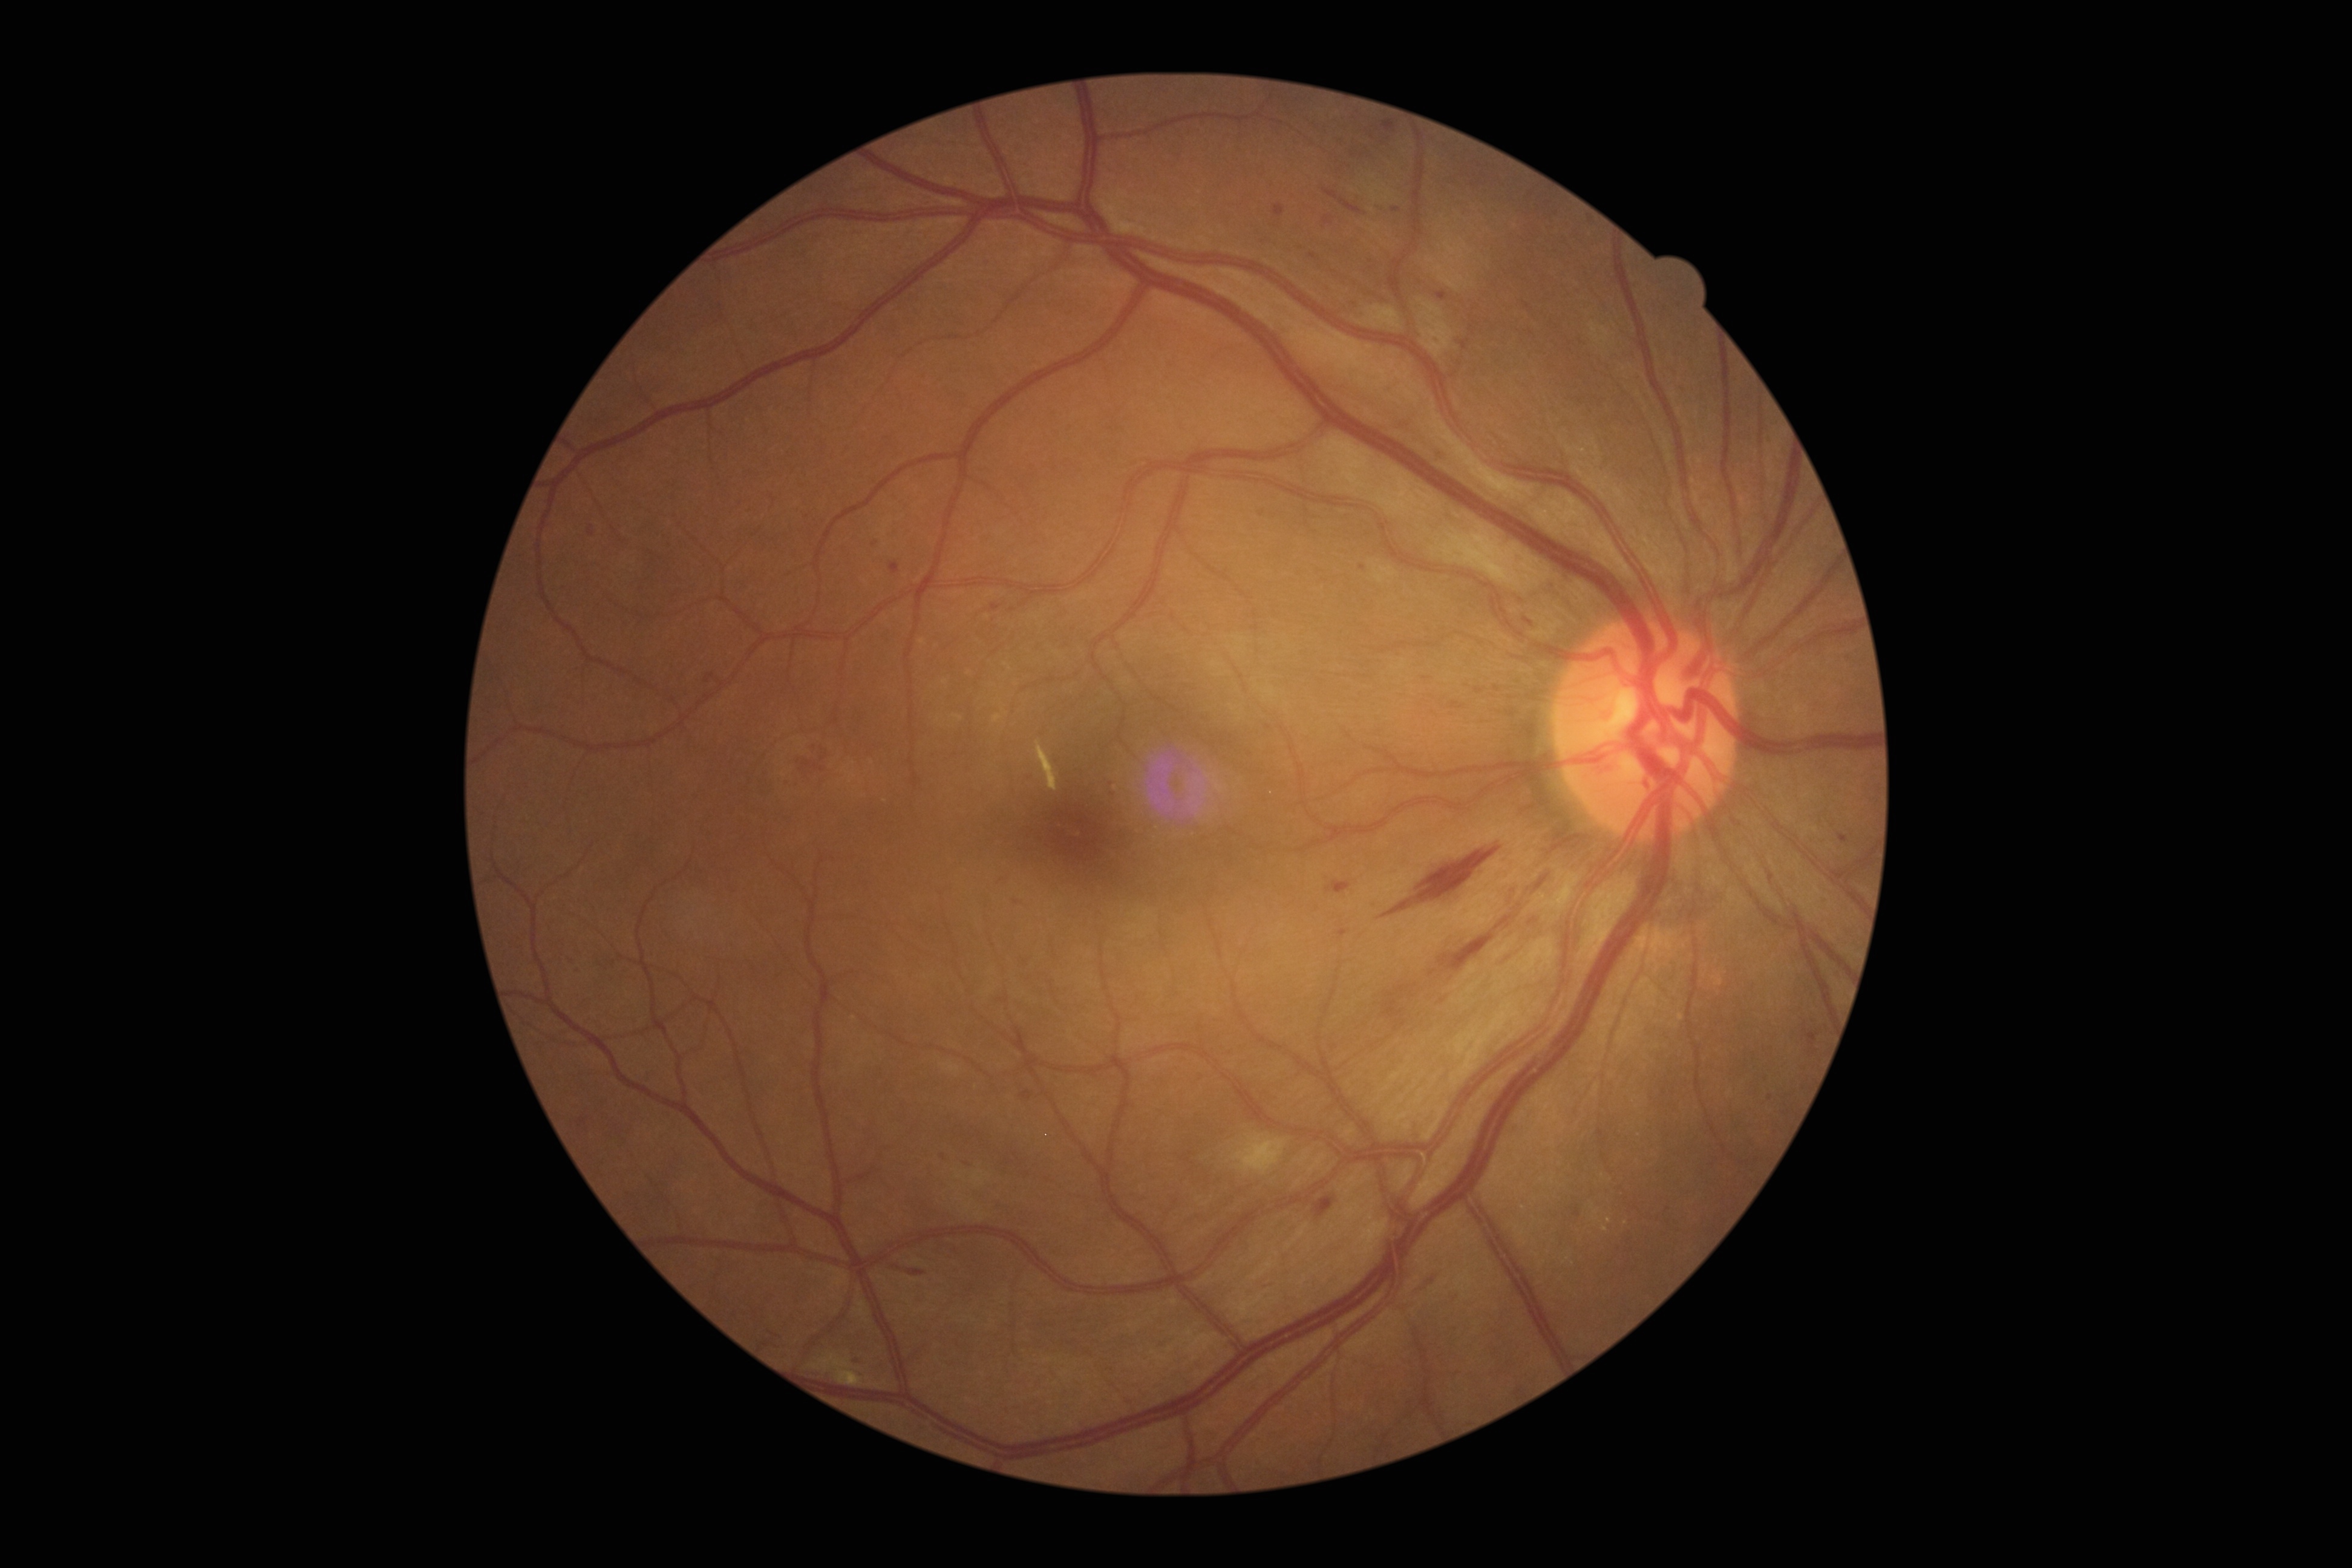
Diabetic retinopathy (DR): grade 2 — more than just microaneurysms but less than severe NPDR.
DR class: non-proliferative diabetic retinopathy.